45° FOV.
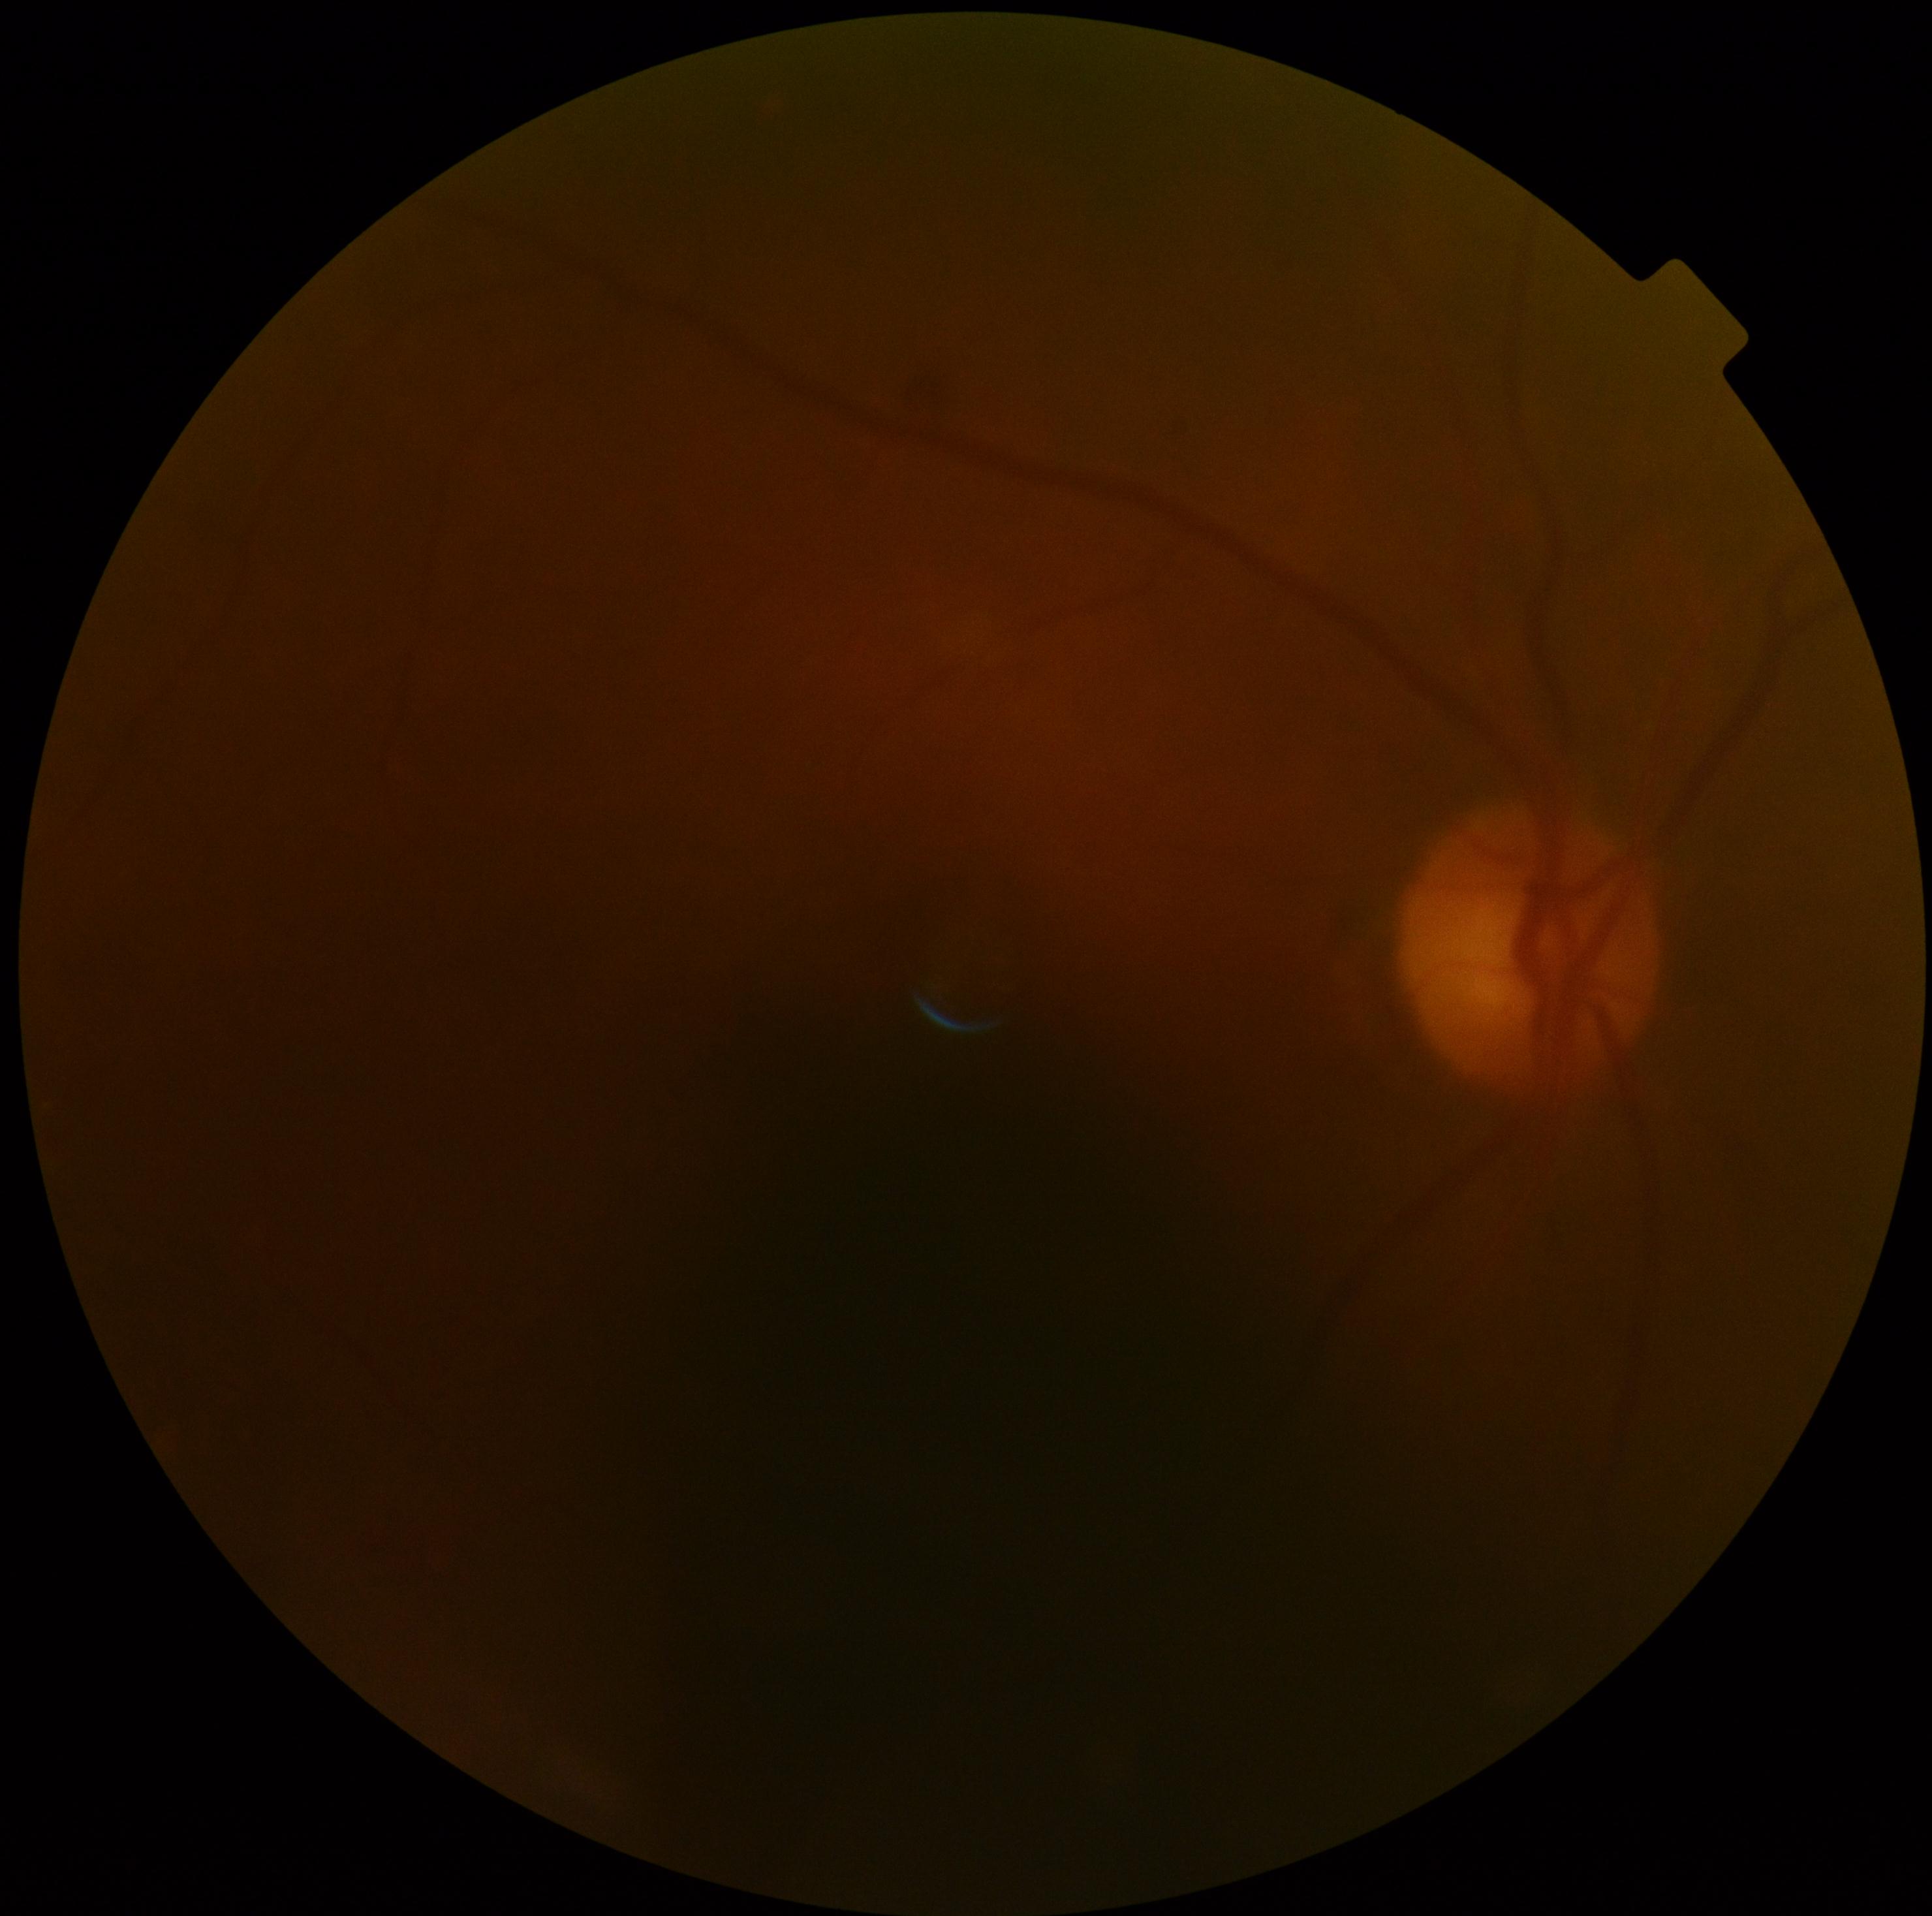
* diabetic retinopathy (DR) — moderate non-proliferative diabetic retinopathy (grade 2) — more than just microaneurysms but less than severe NPDR